Fundus photo
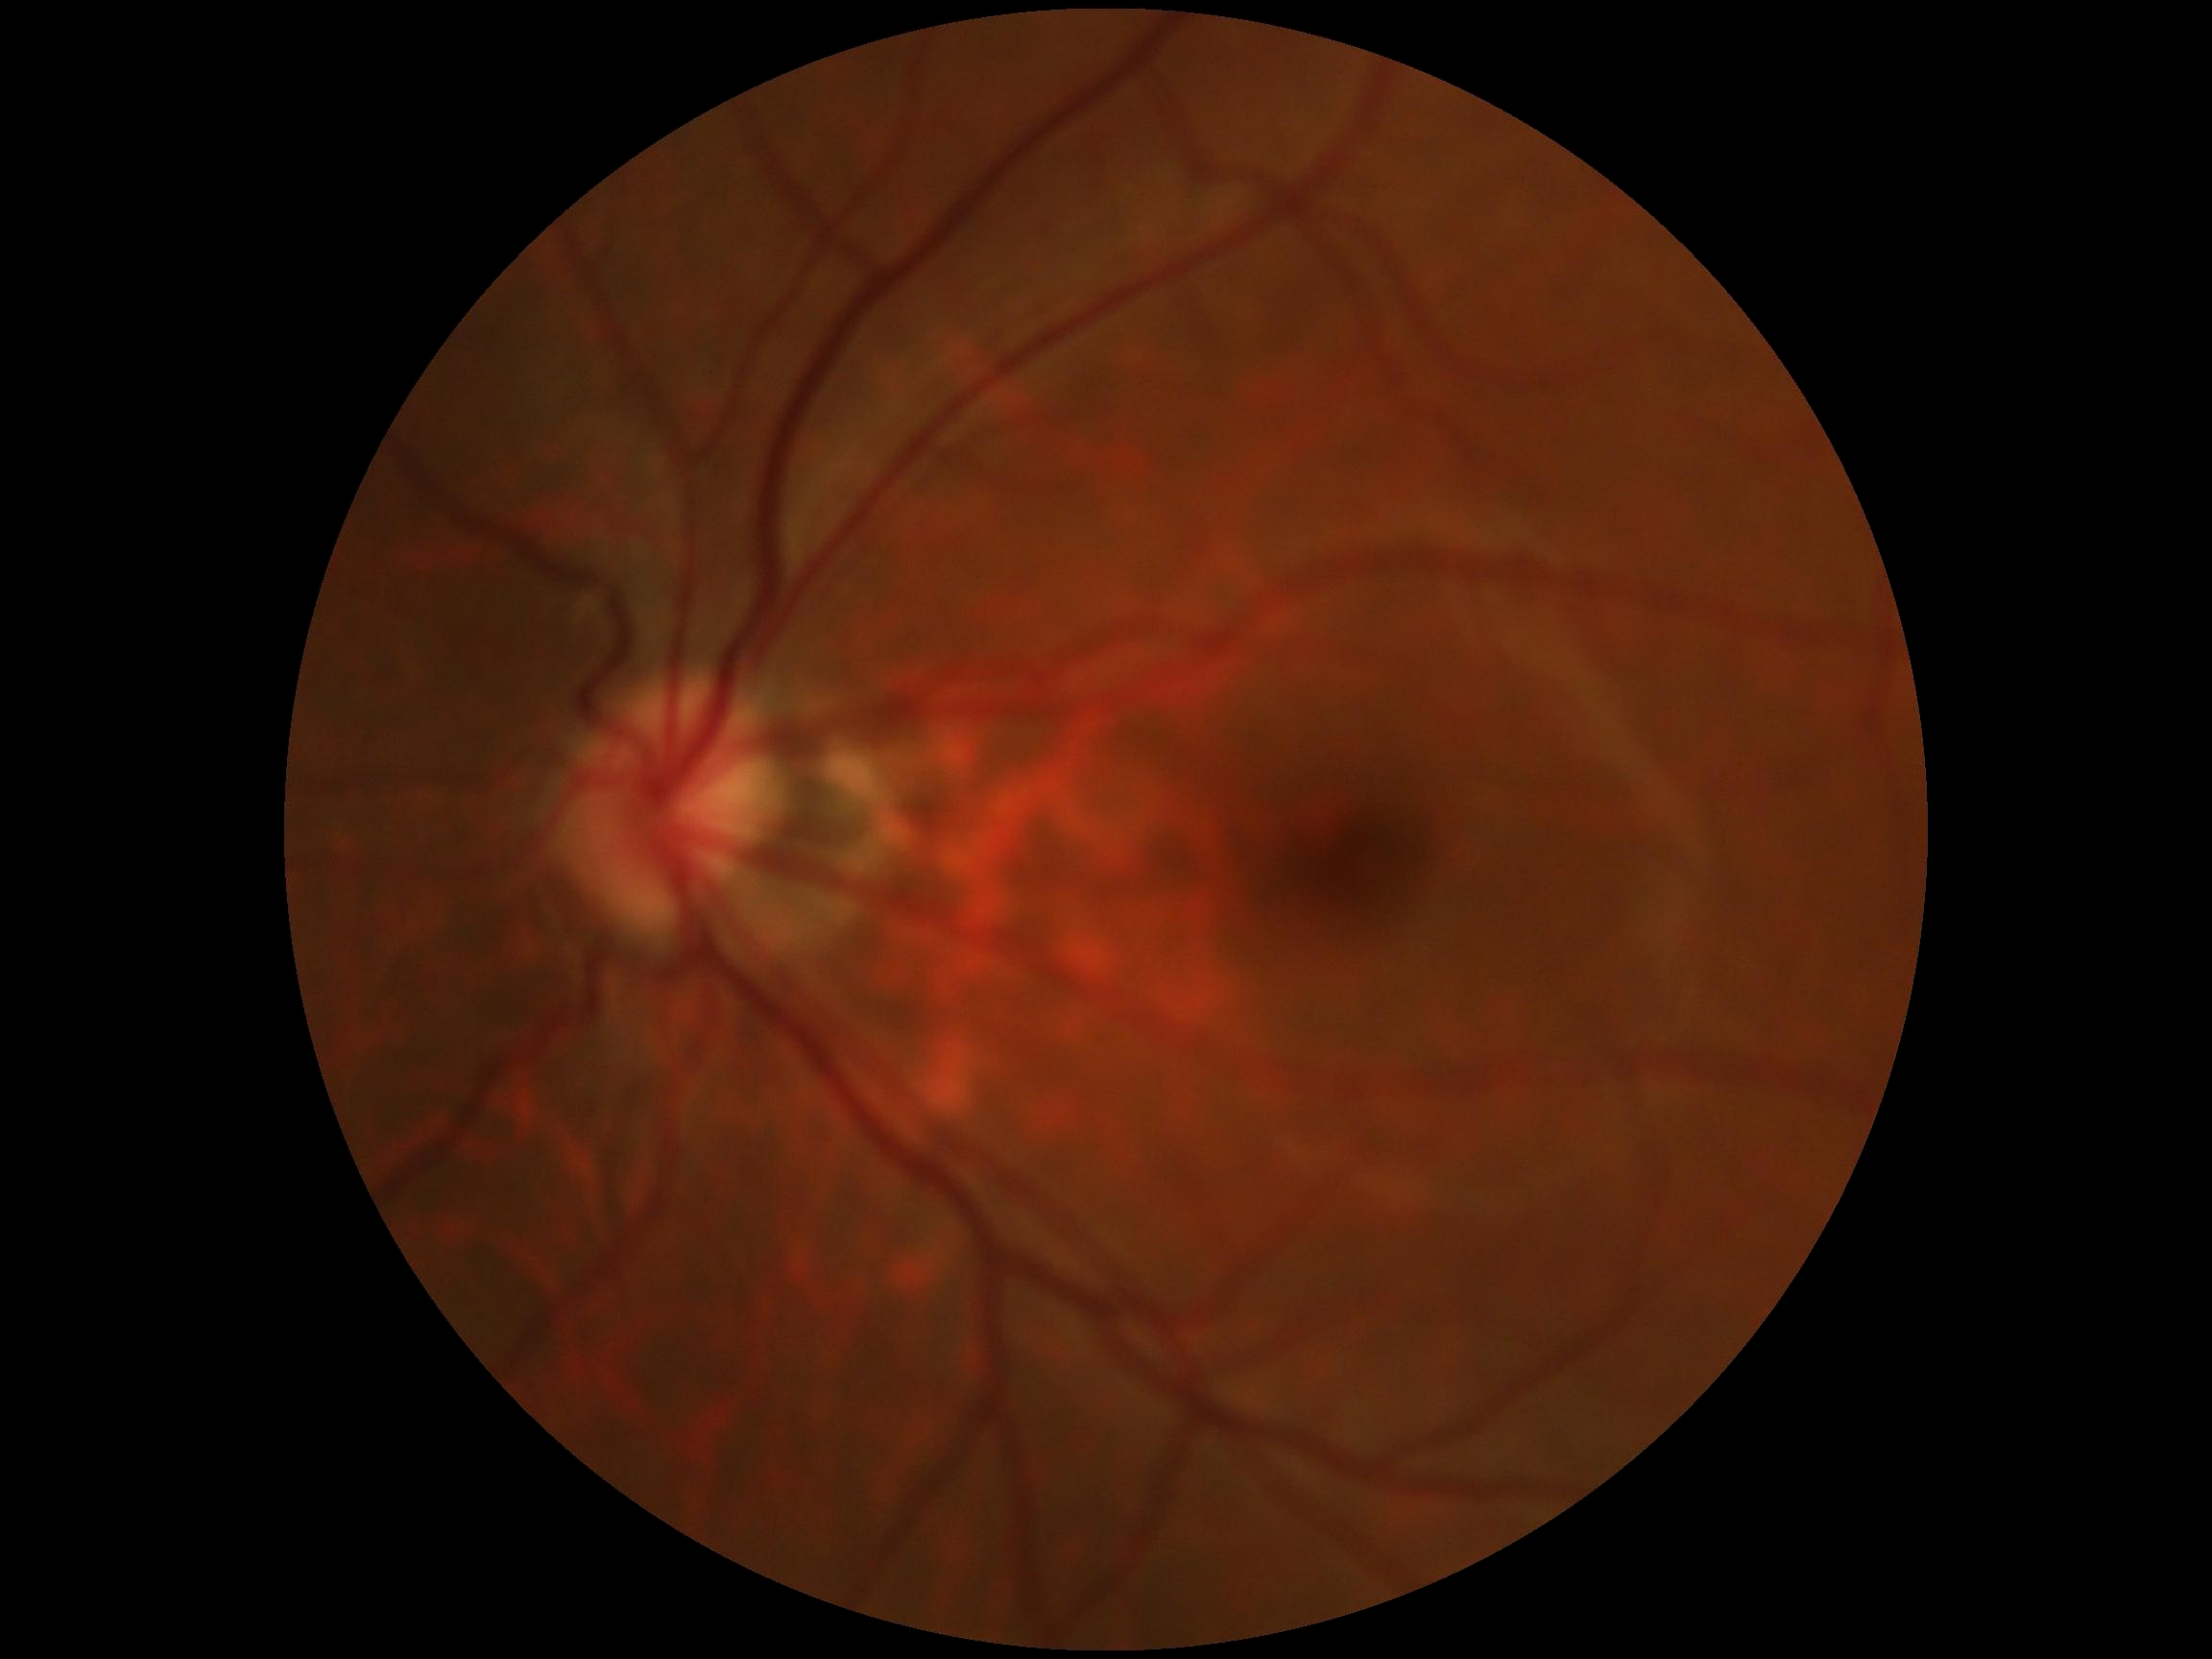

No signs of diabetic retinopathy.
DR grade is 0 — no visible signs of diabetic retinopathy.